Color fundus photograph:
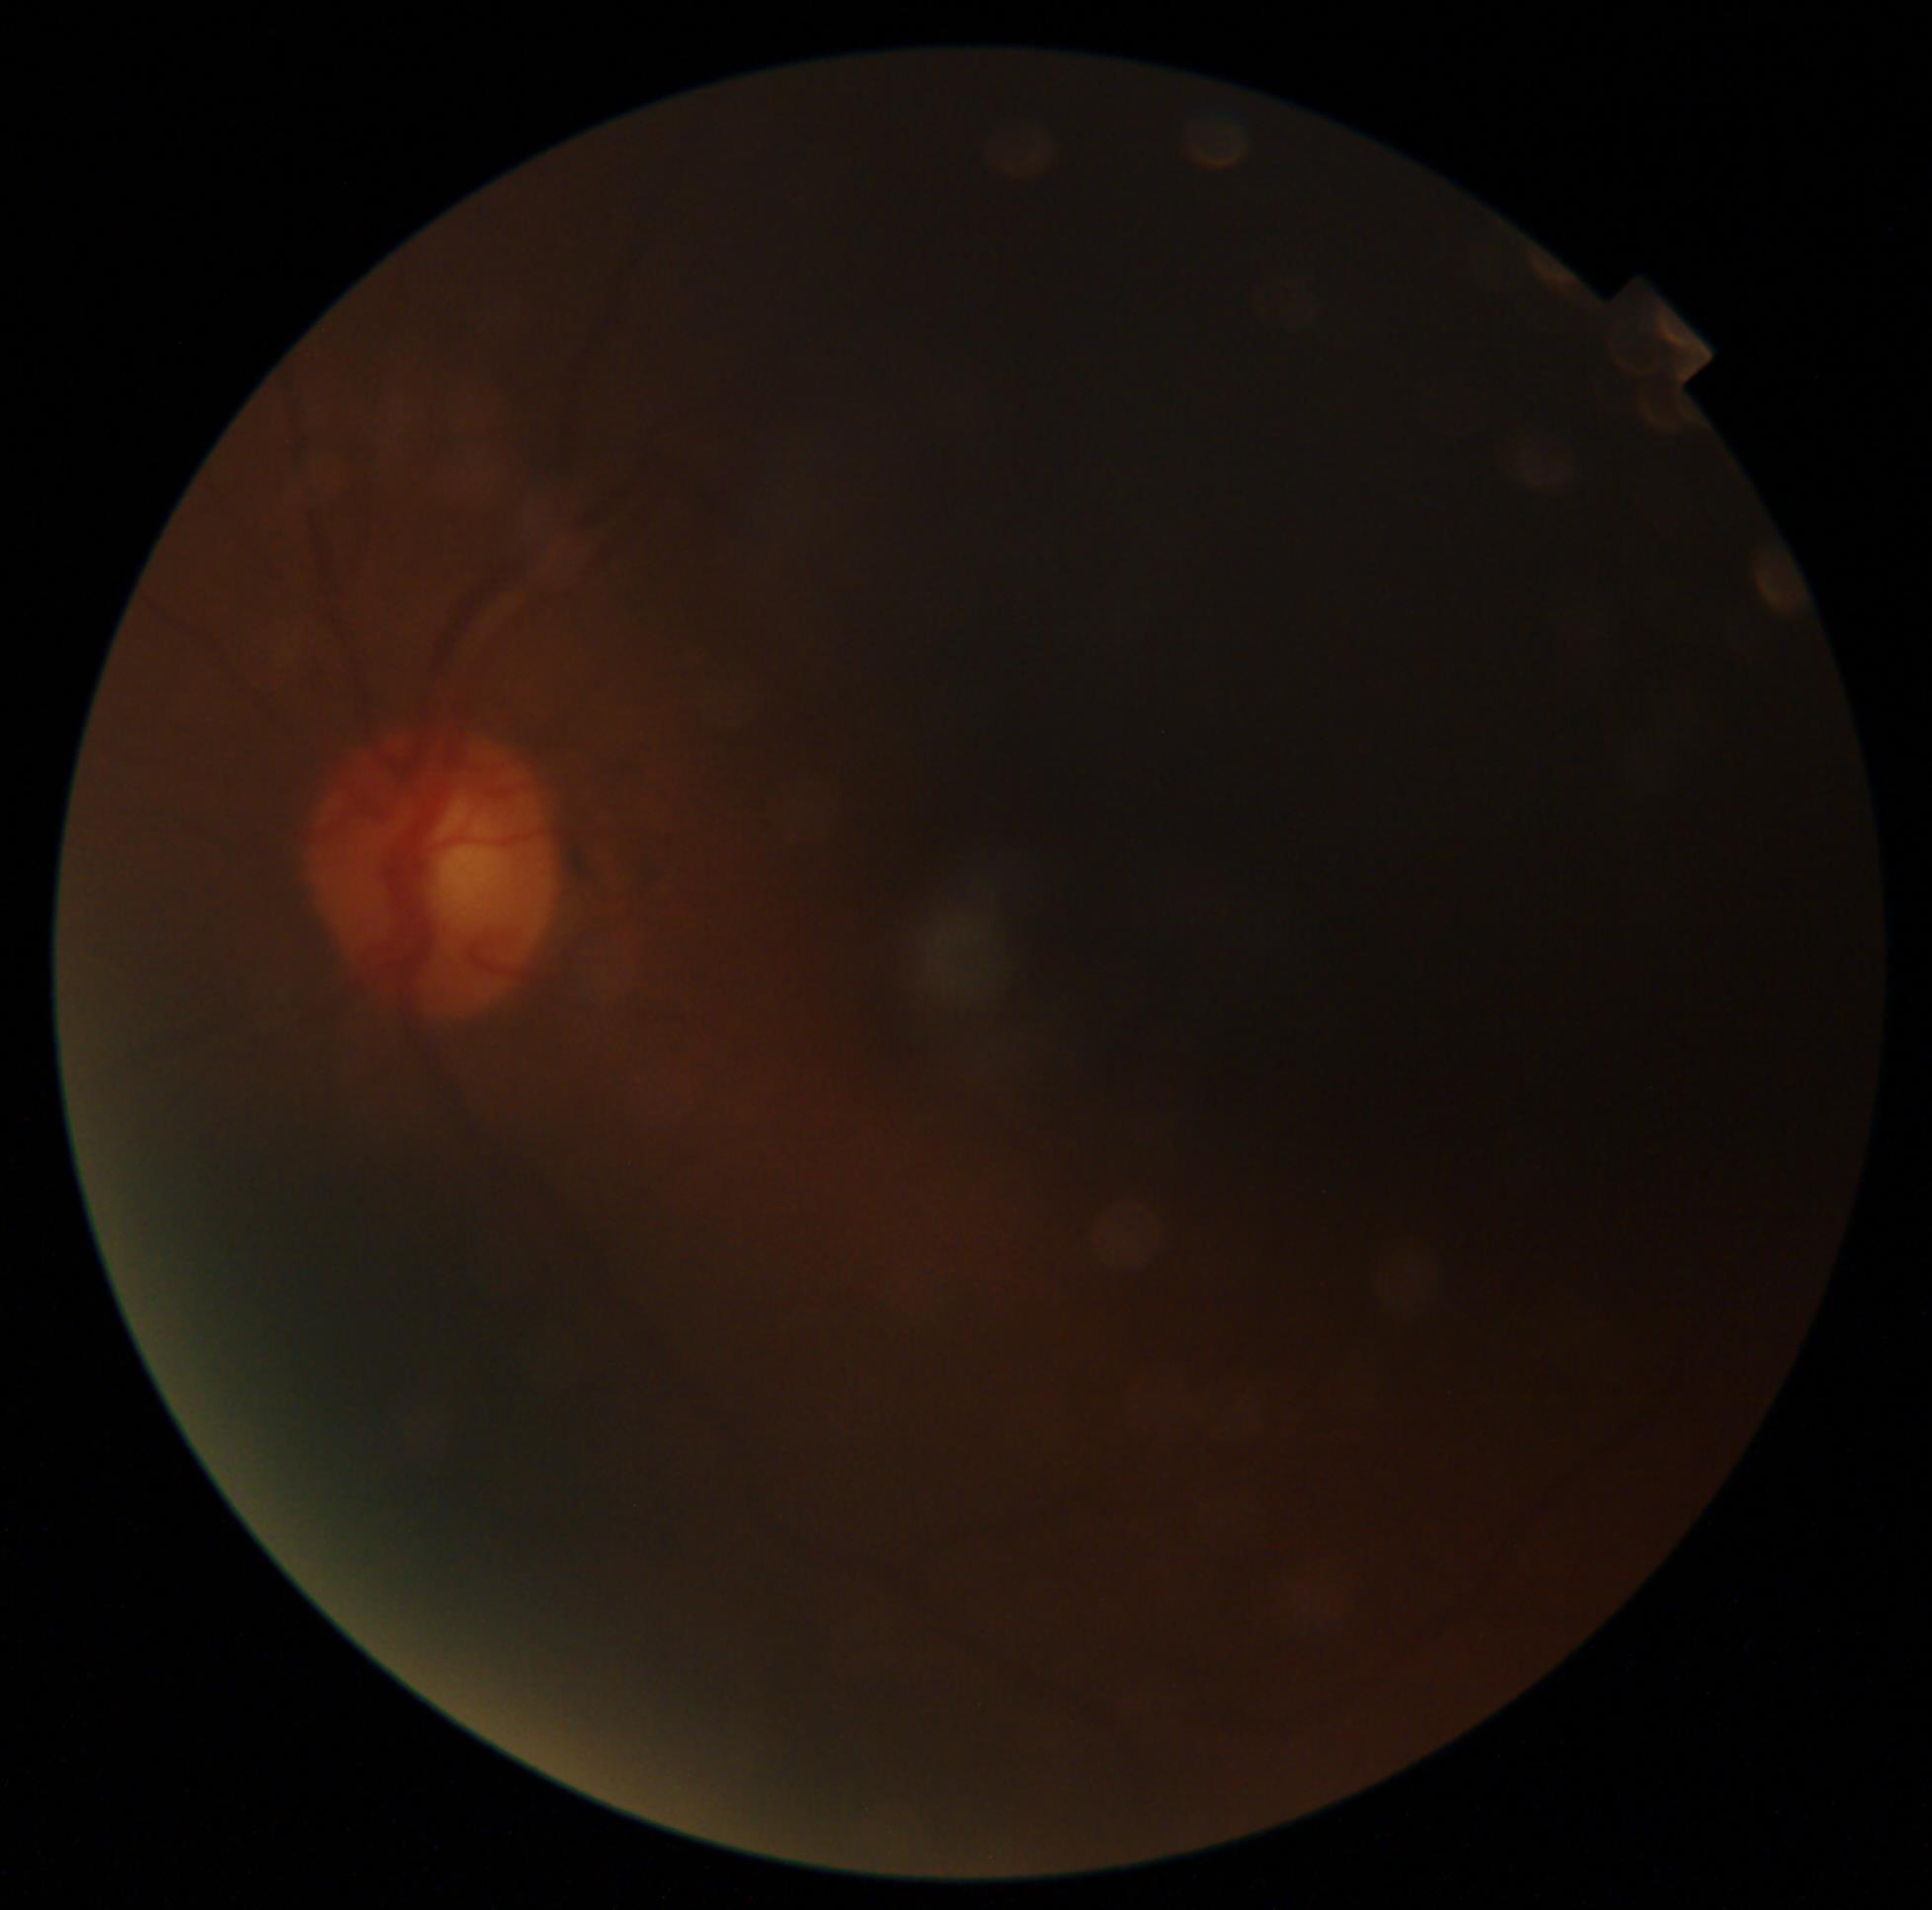

image quality=below grading threshold, DR severity=ungradable due to poor image quality.